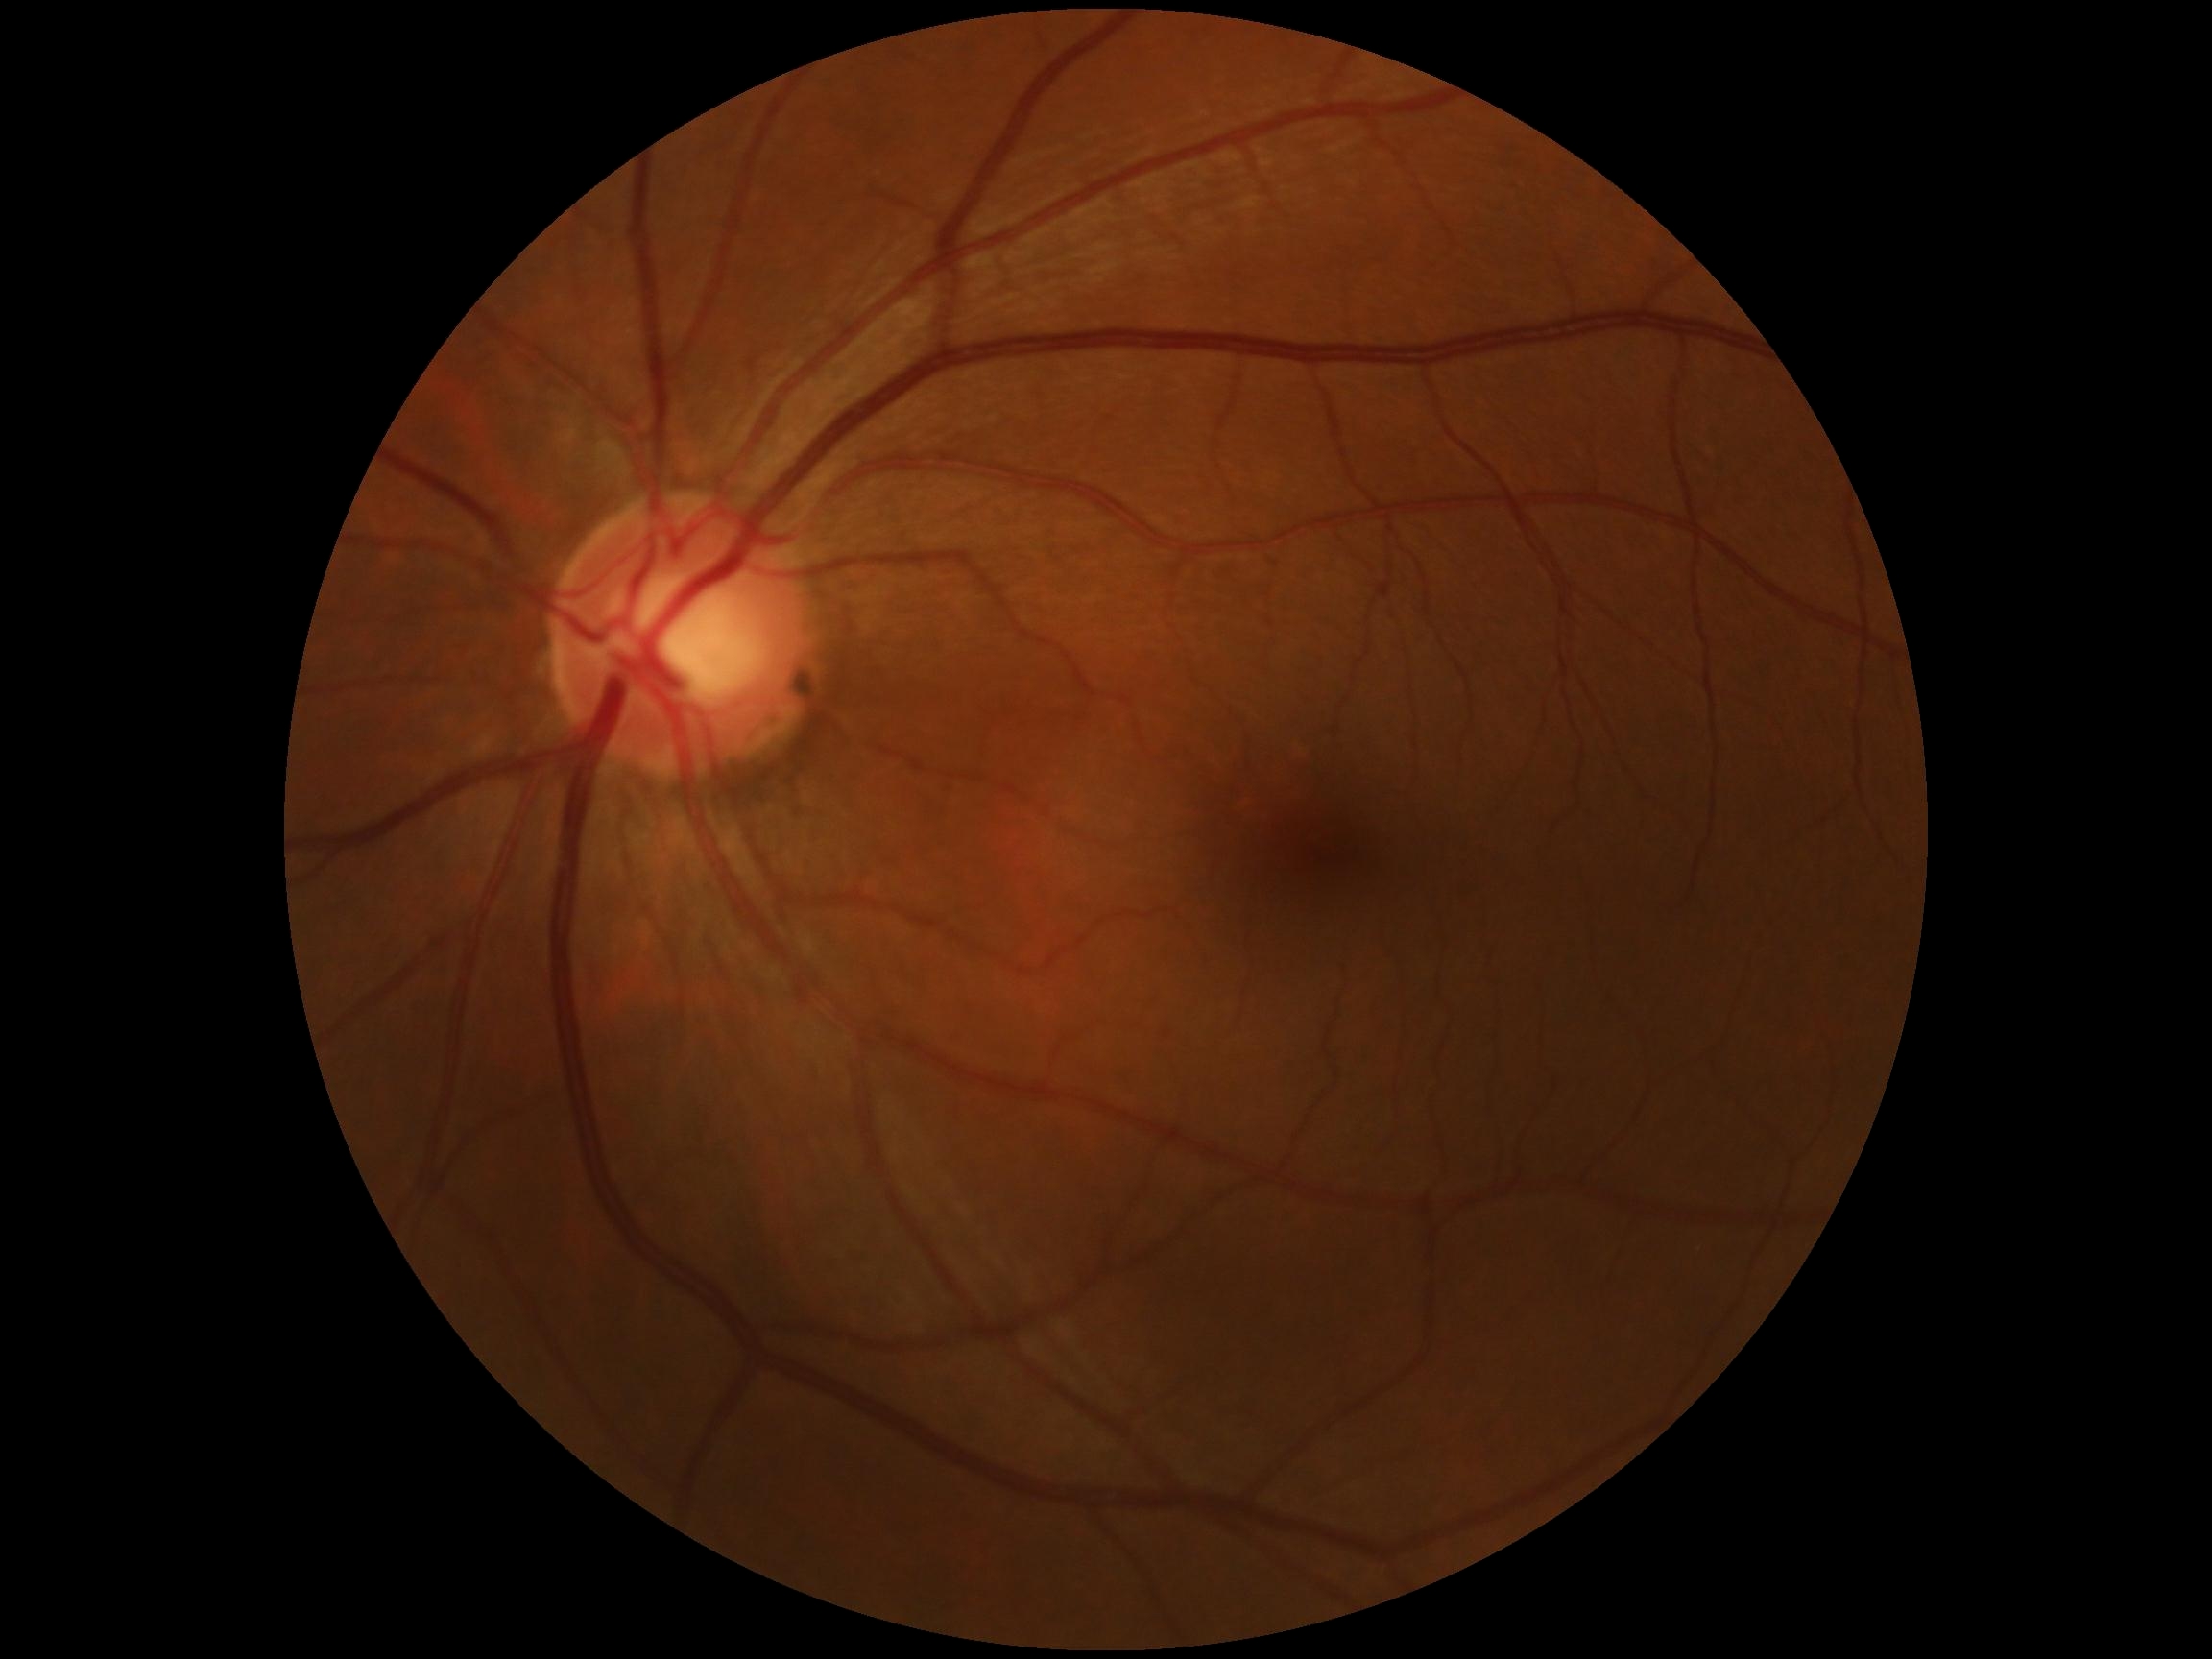

retinopathy grade: 0 (no apparent retinopathy).